NIDEK AFC-230
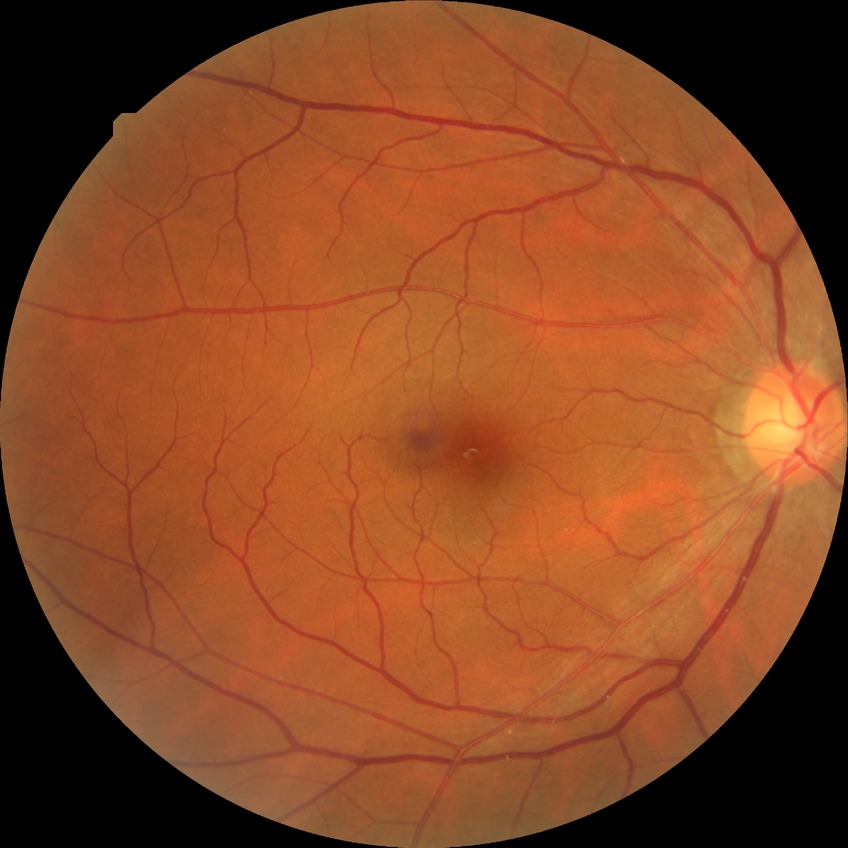

Davis grading is no diabetic retinopathy.